Captured on a Remidio Fundus on Phone (FOP) camera.
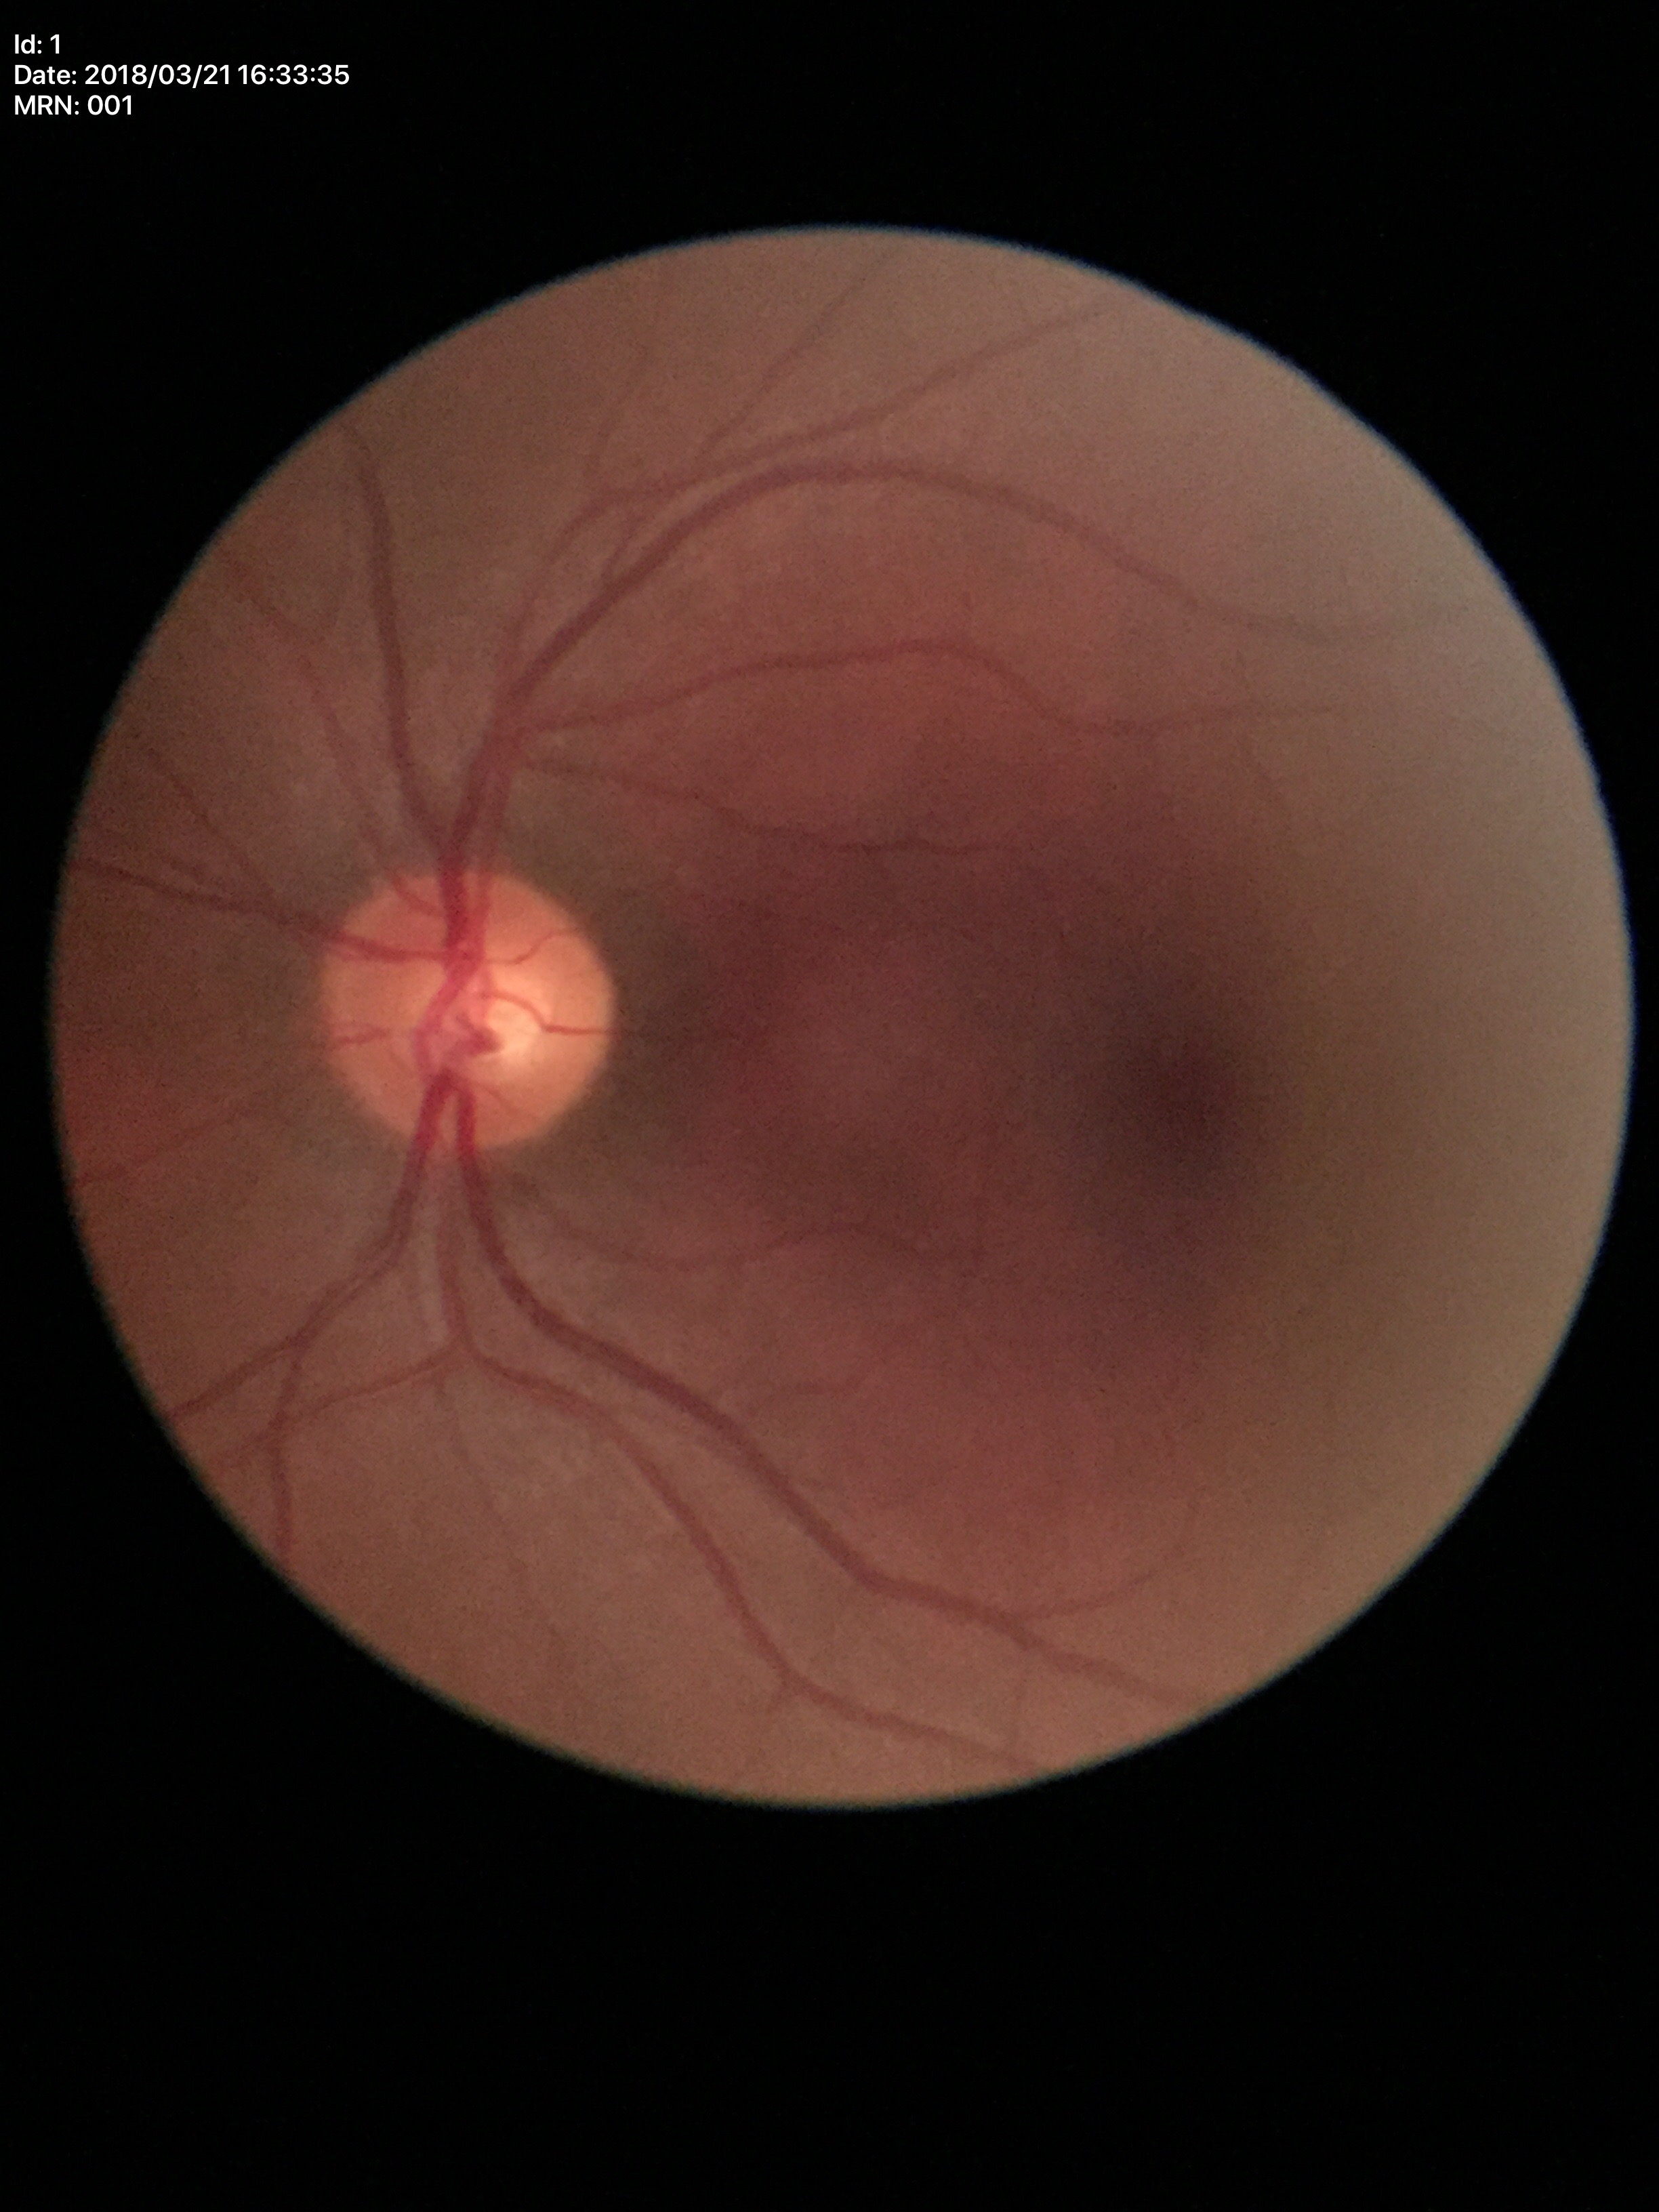
Glaucoma evaluation=no suspicious findings; vertical C/D ratio (VCDR)=0.49; horizontal cup-to-disc ratio (HCDR)=0.52